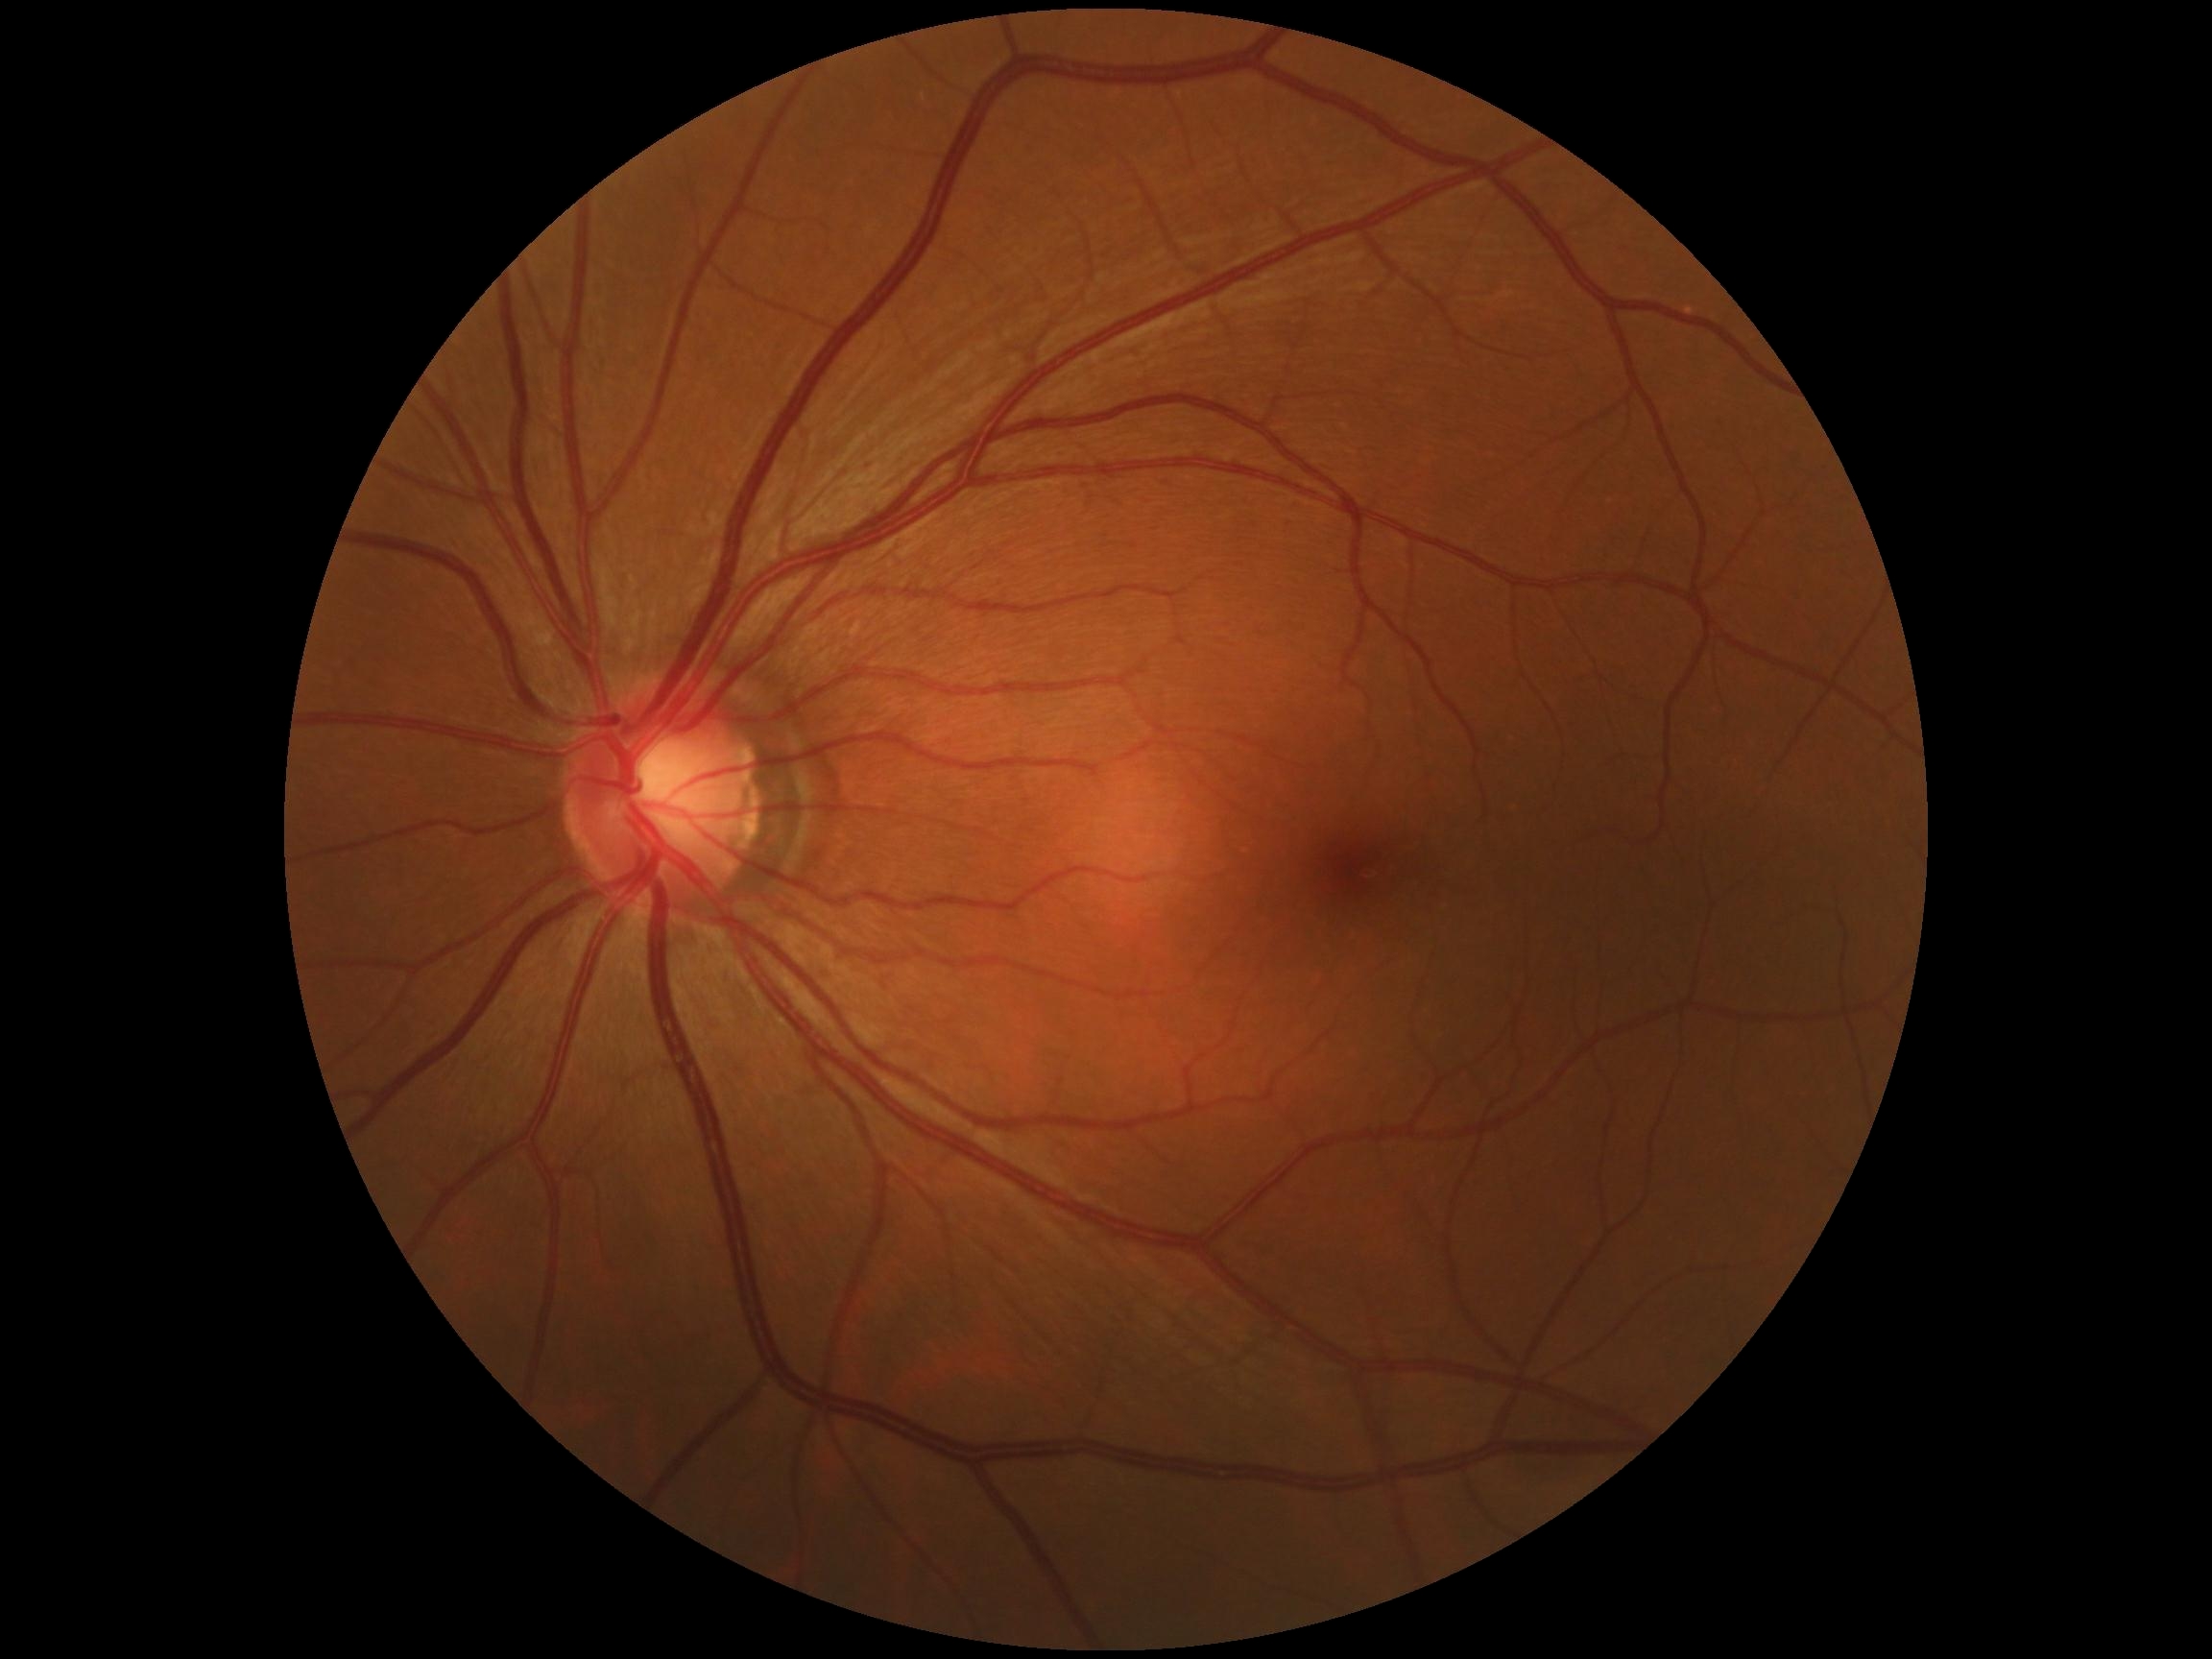
DR severity = grade 0.